Infant wide-field fundus photograph. Image size 1240x1240: 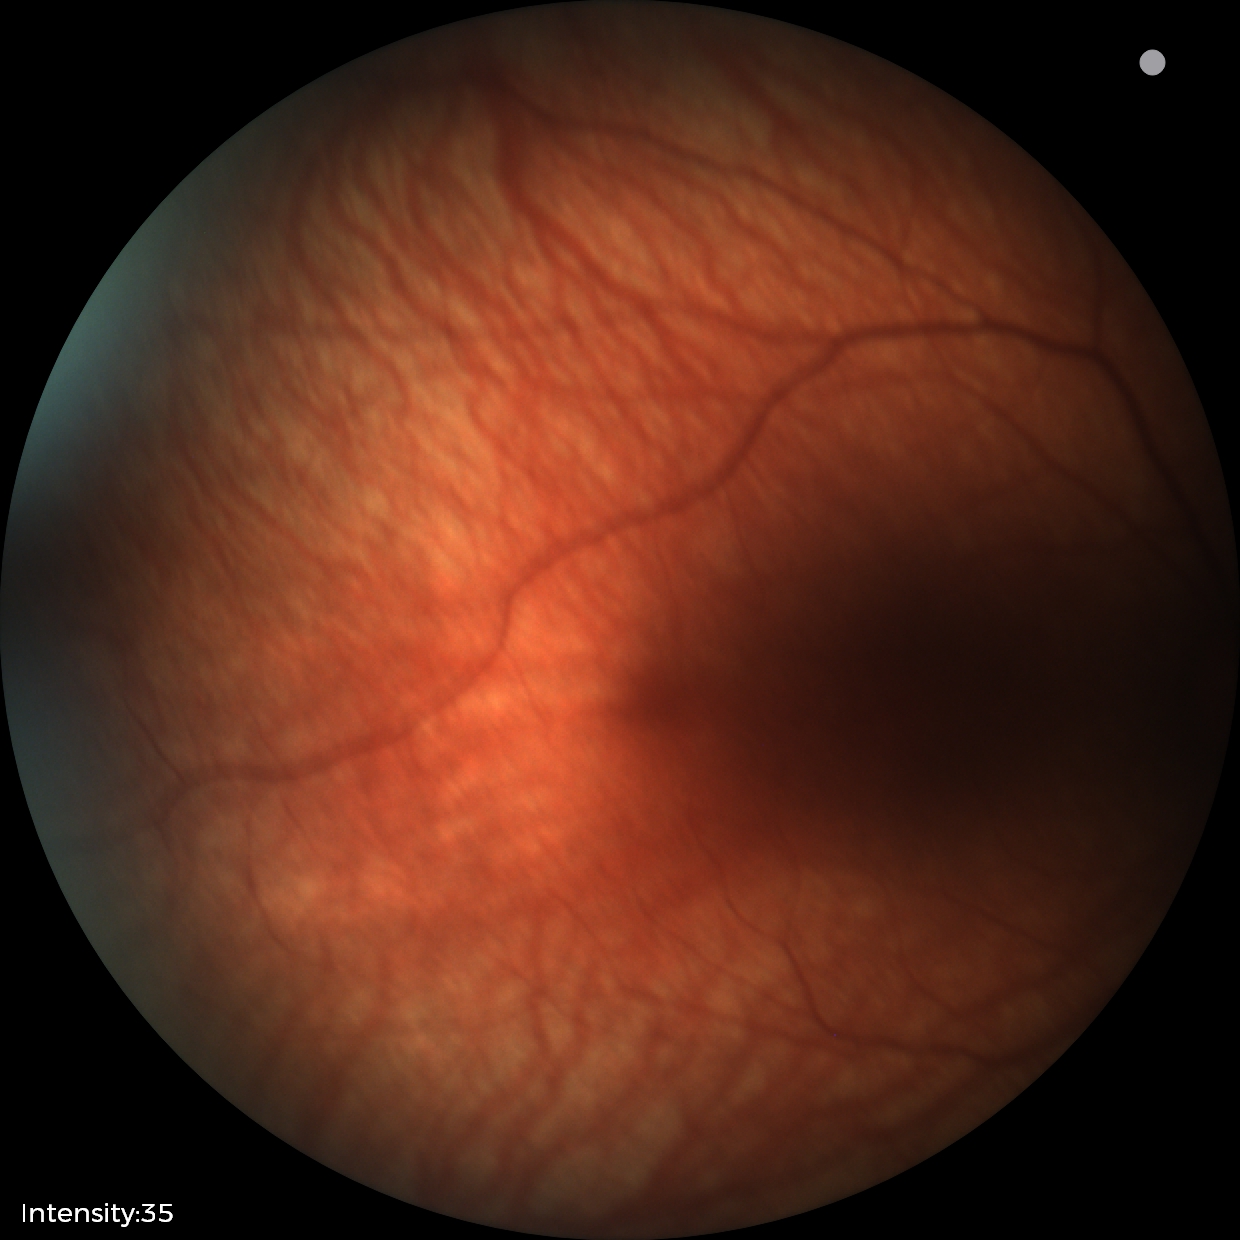

Screening examination with no abnormal retinal findings.